Modified Davis grading
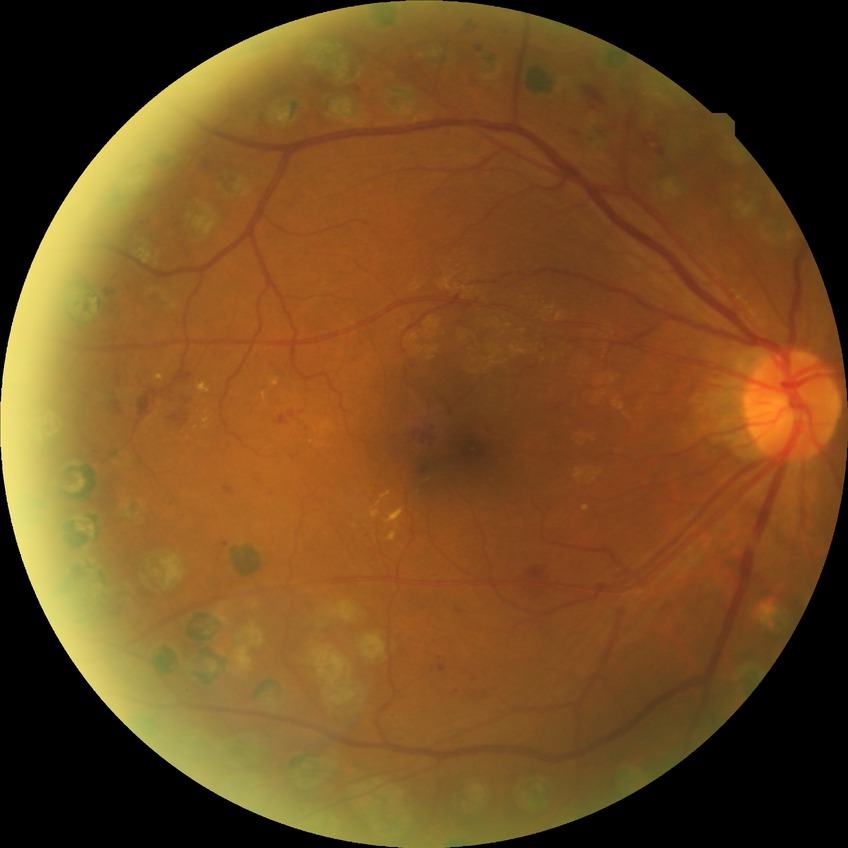
Davis grading: proliferative diabetic retinopathy.